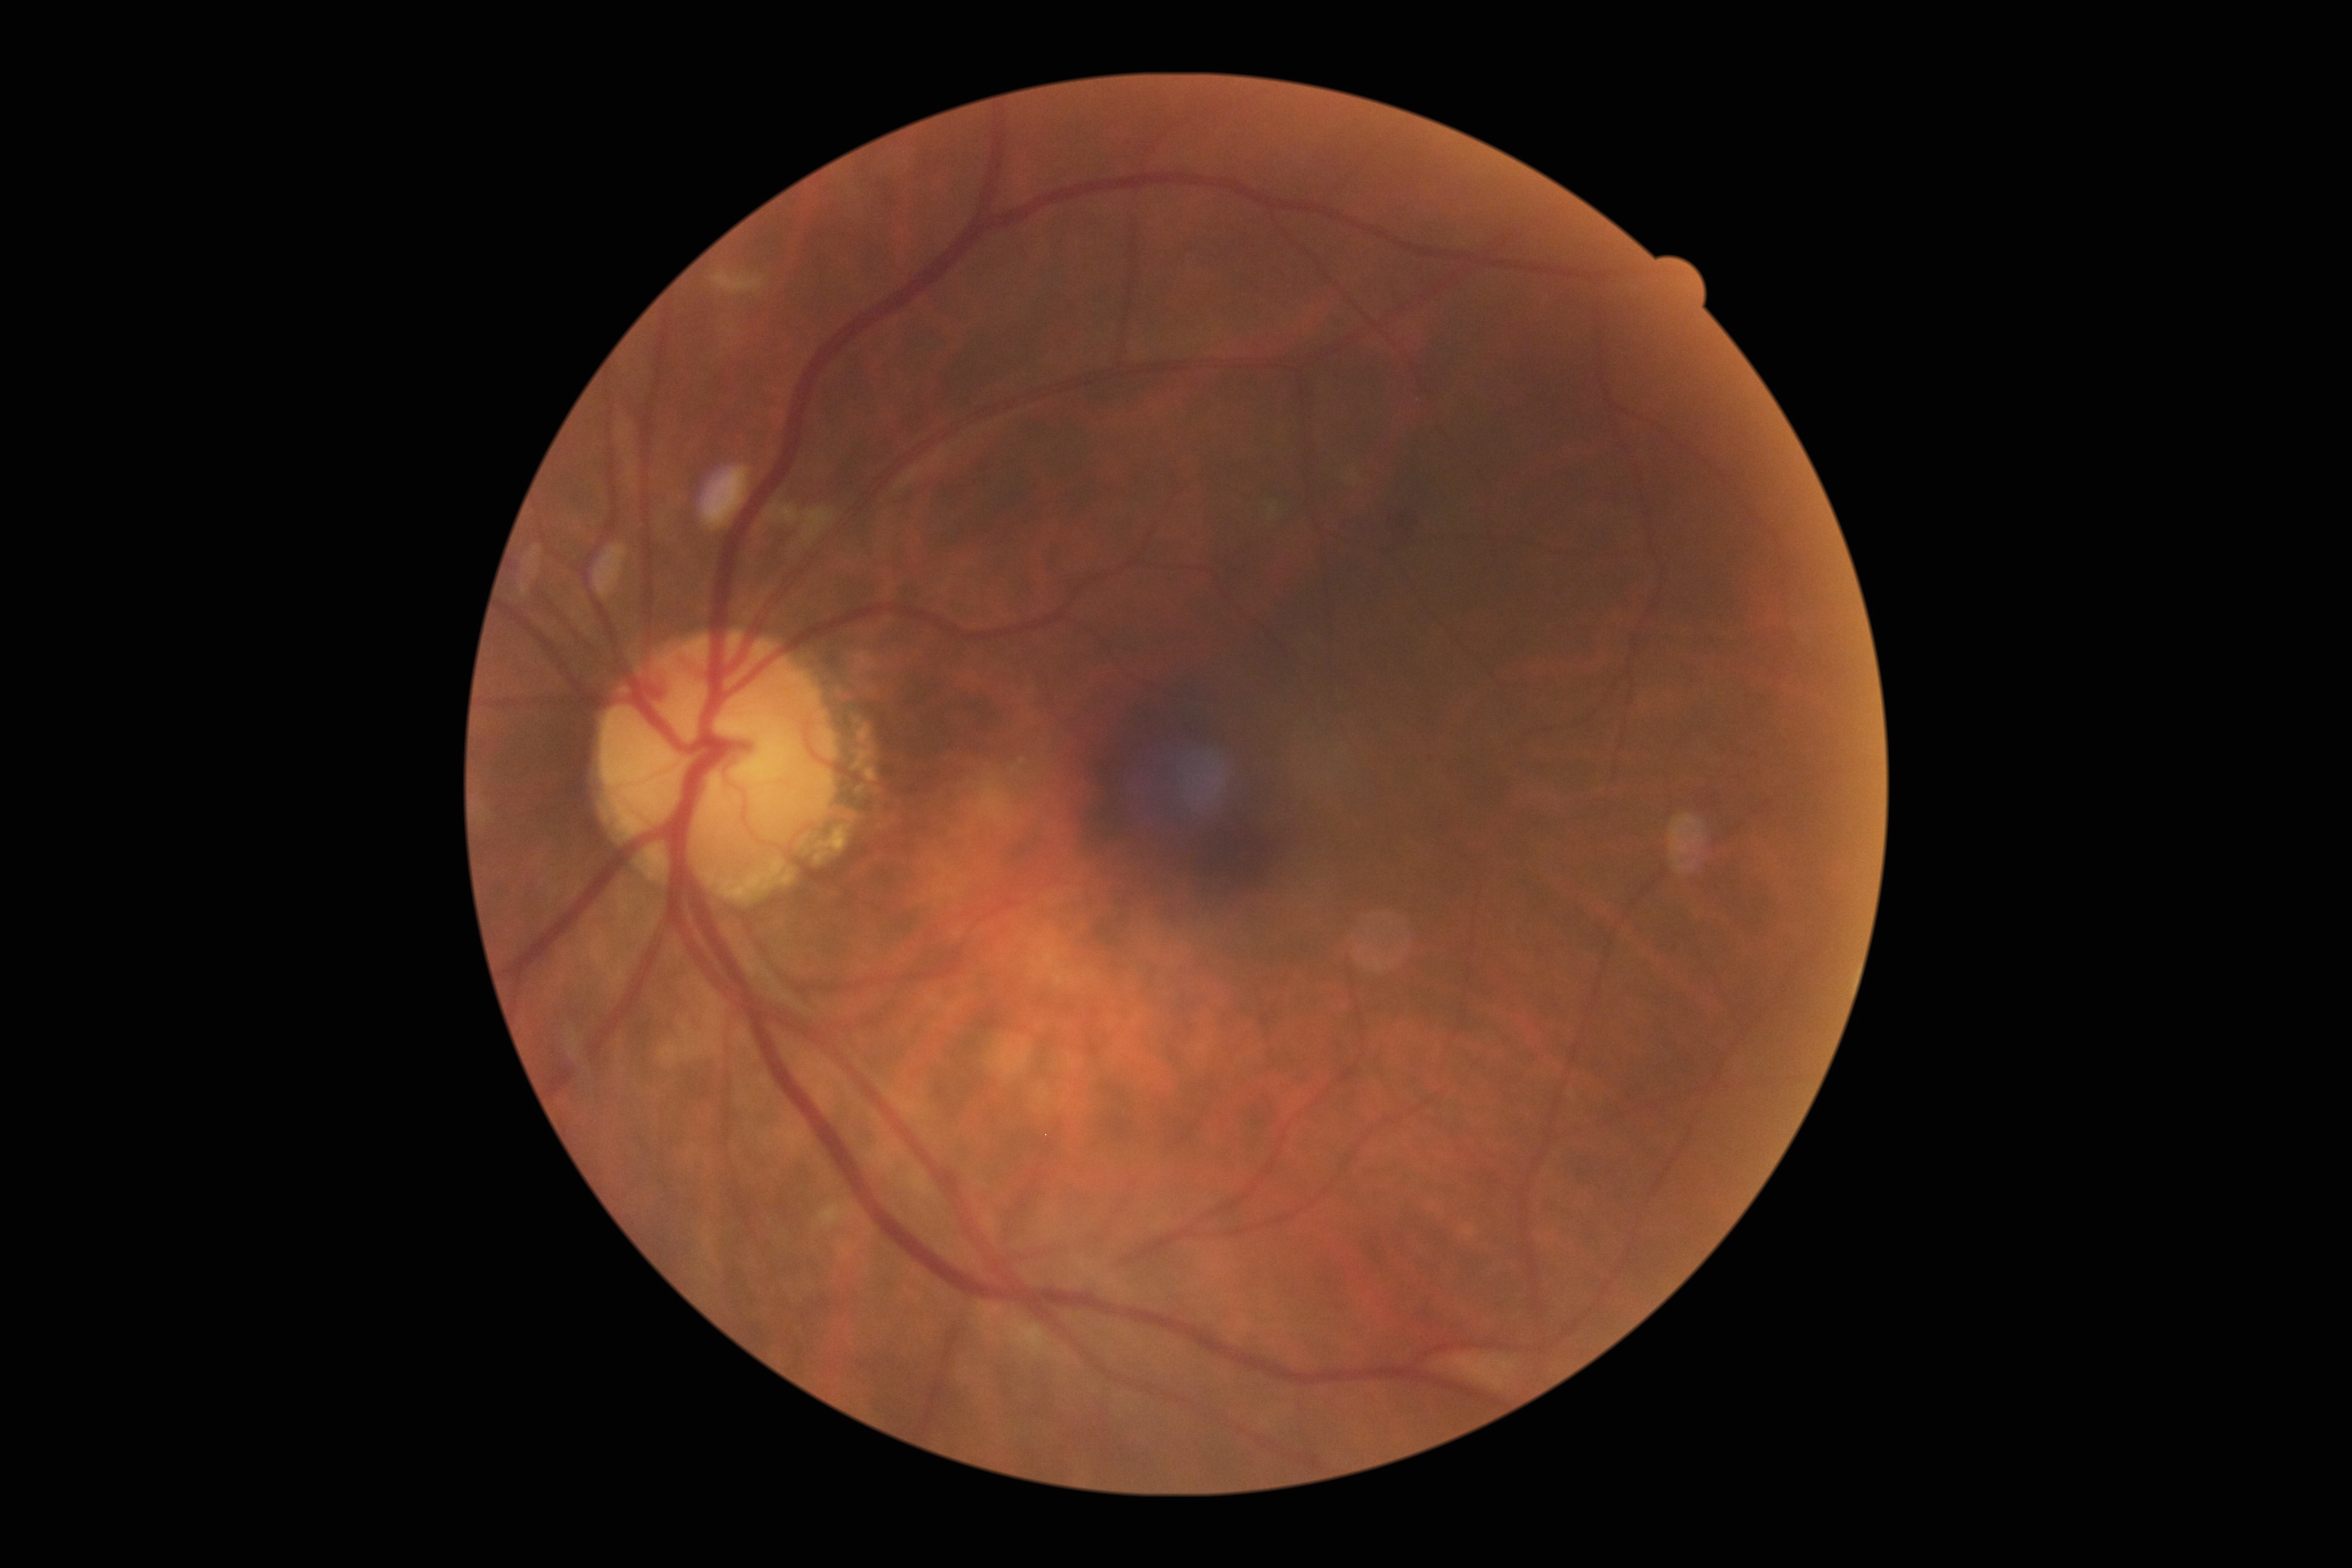 Diabetic retinopathy (DR): 2/4.